Wide-field fundus photograph of an infant
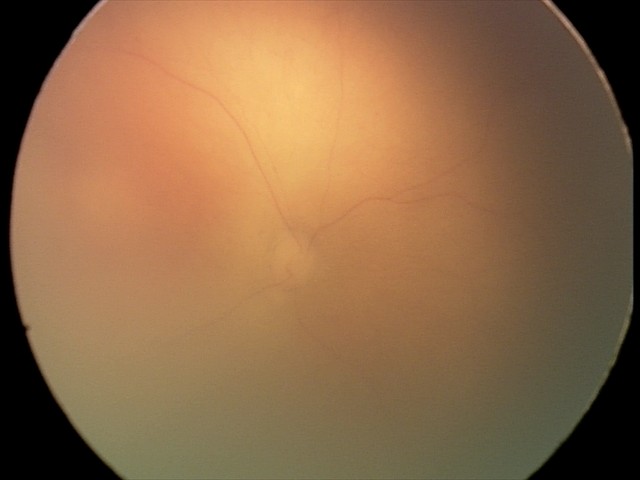

Series diagnosed as retinopathy of prematurity (ROP) stage 0 — incomplete retinal vascularization without a demarcation line.